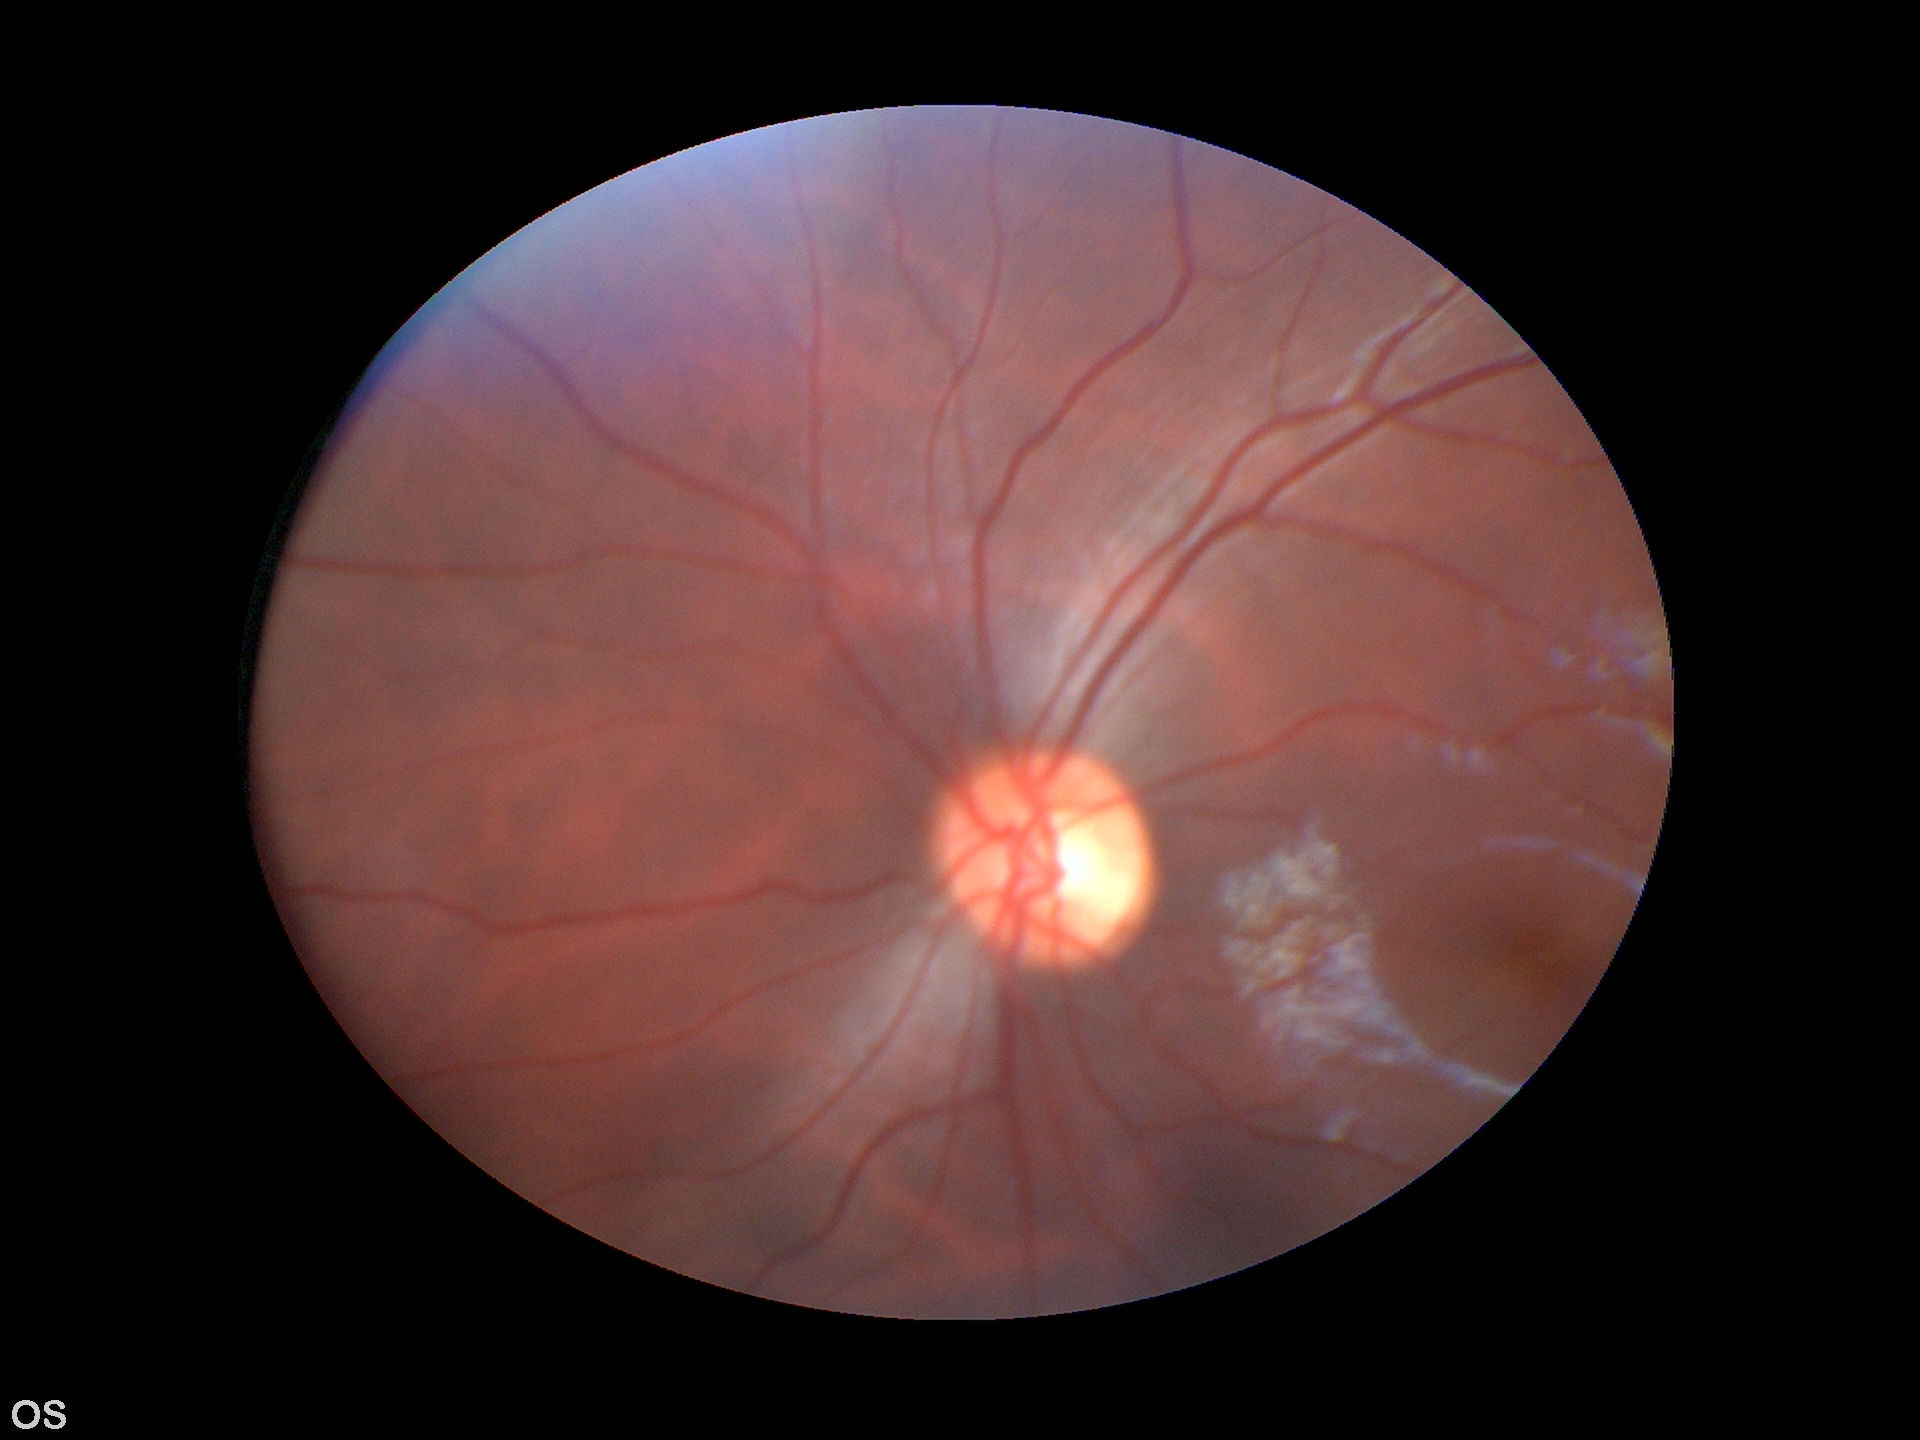 Not suspicious for glaucoma.
Vertical C/D ratio (VCDR): 0.53.
Area cup-disc ratio (ACDR): 0.28.
Horizontal cup-to-disc ratio (HCDR): 0.53.